Posterior pole photograph
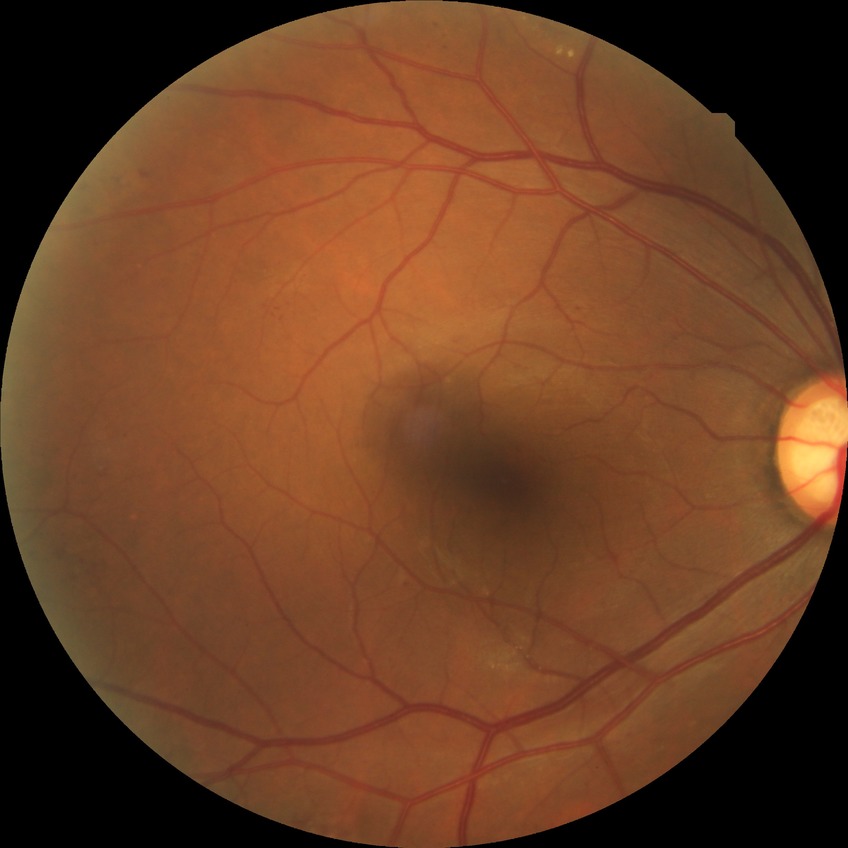
Diabetic retinopathy (DR) is simple diabetic retinopathy (SDR). Disease class: non-proliferative diabetic retinopathy.